1932x1916px.
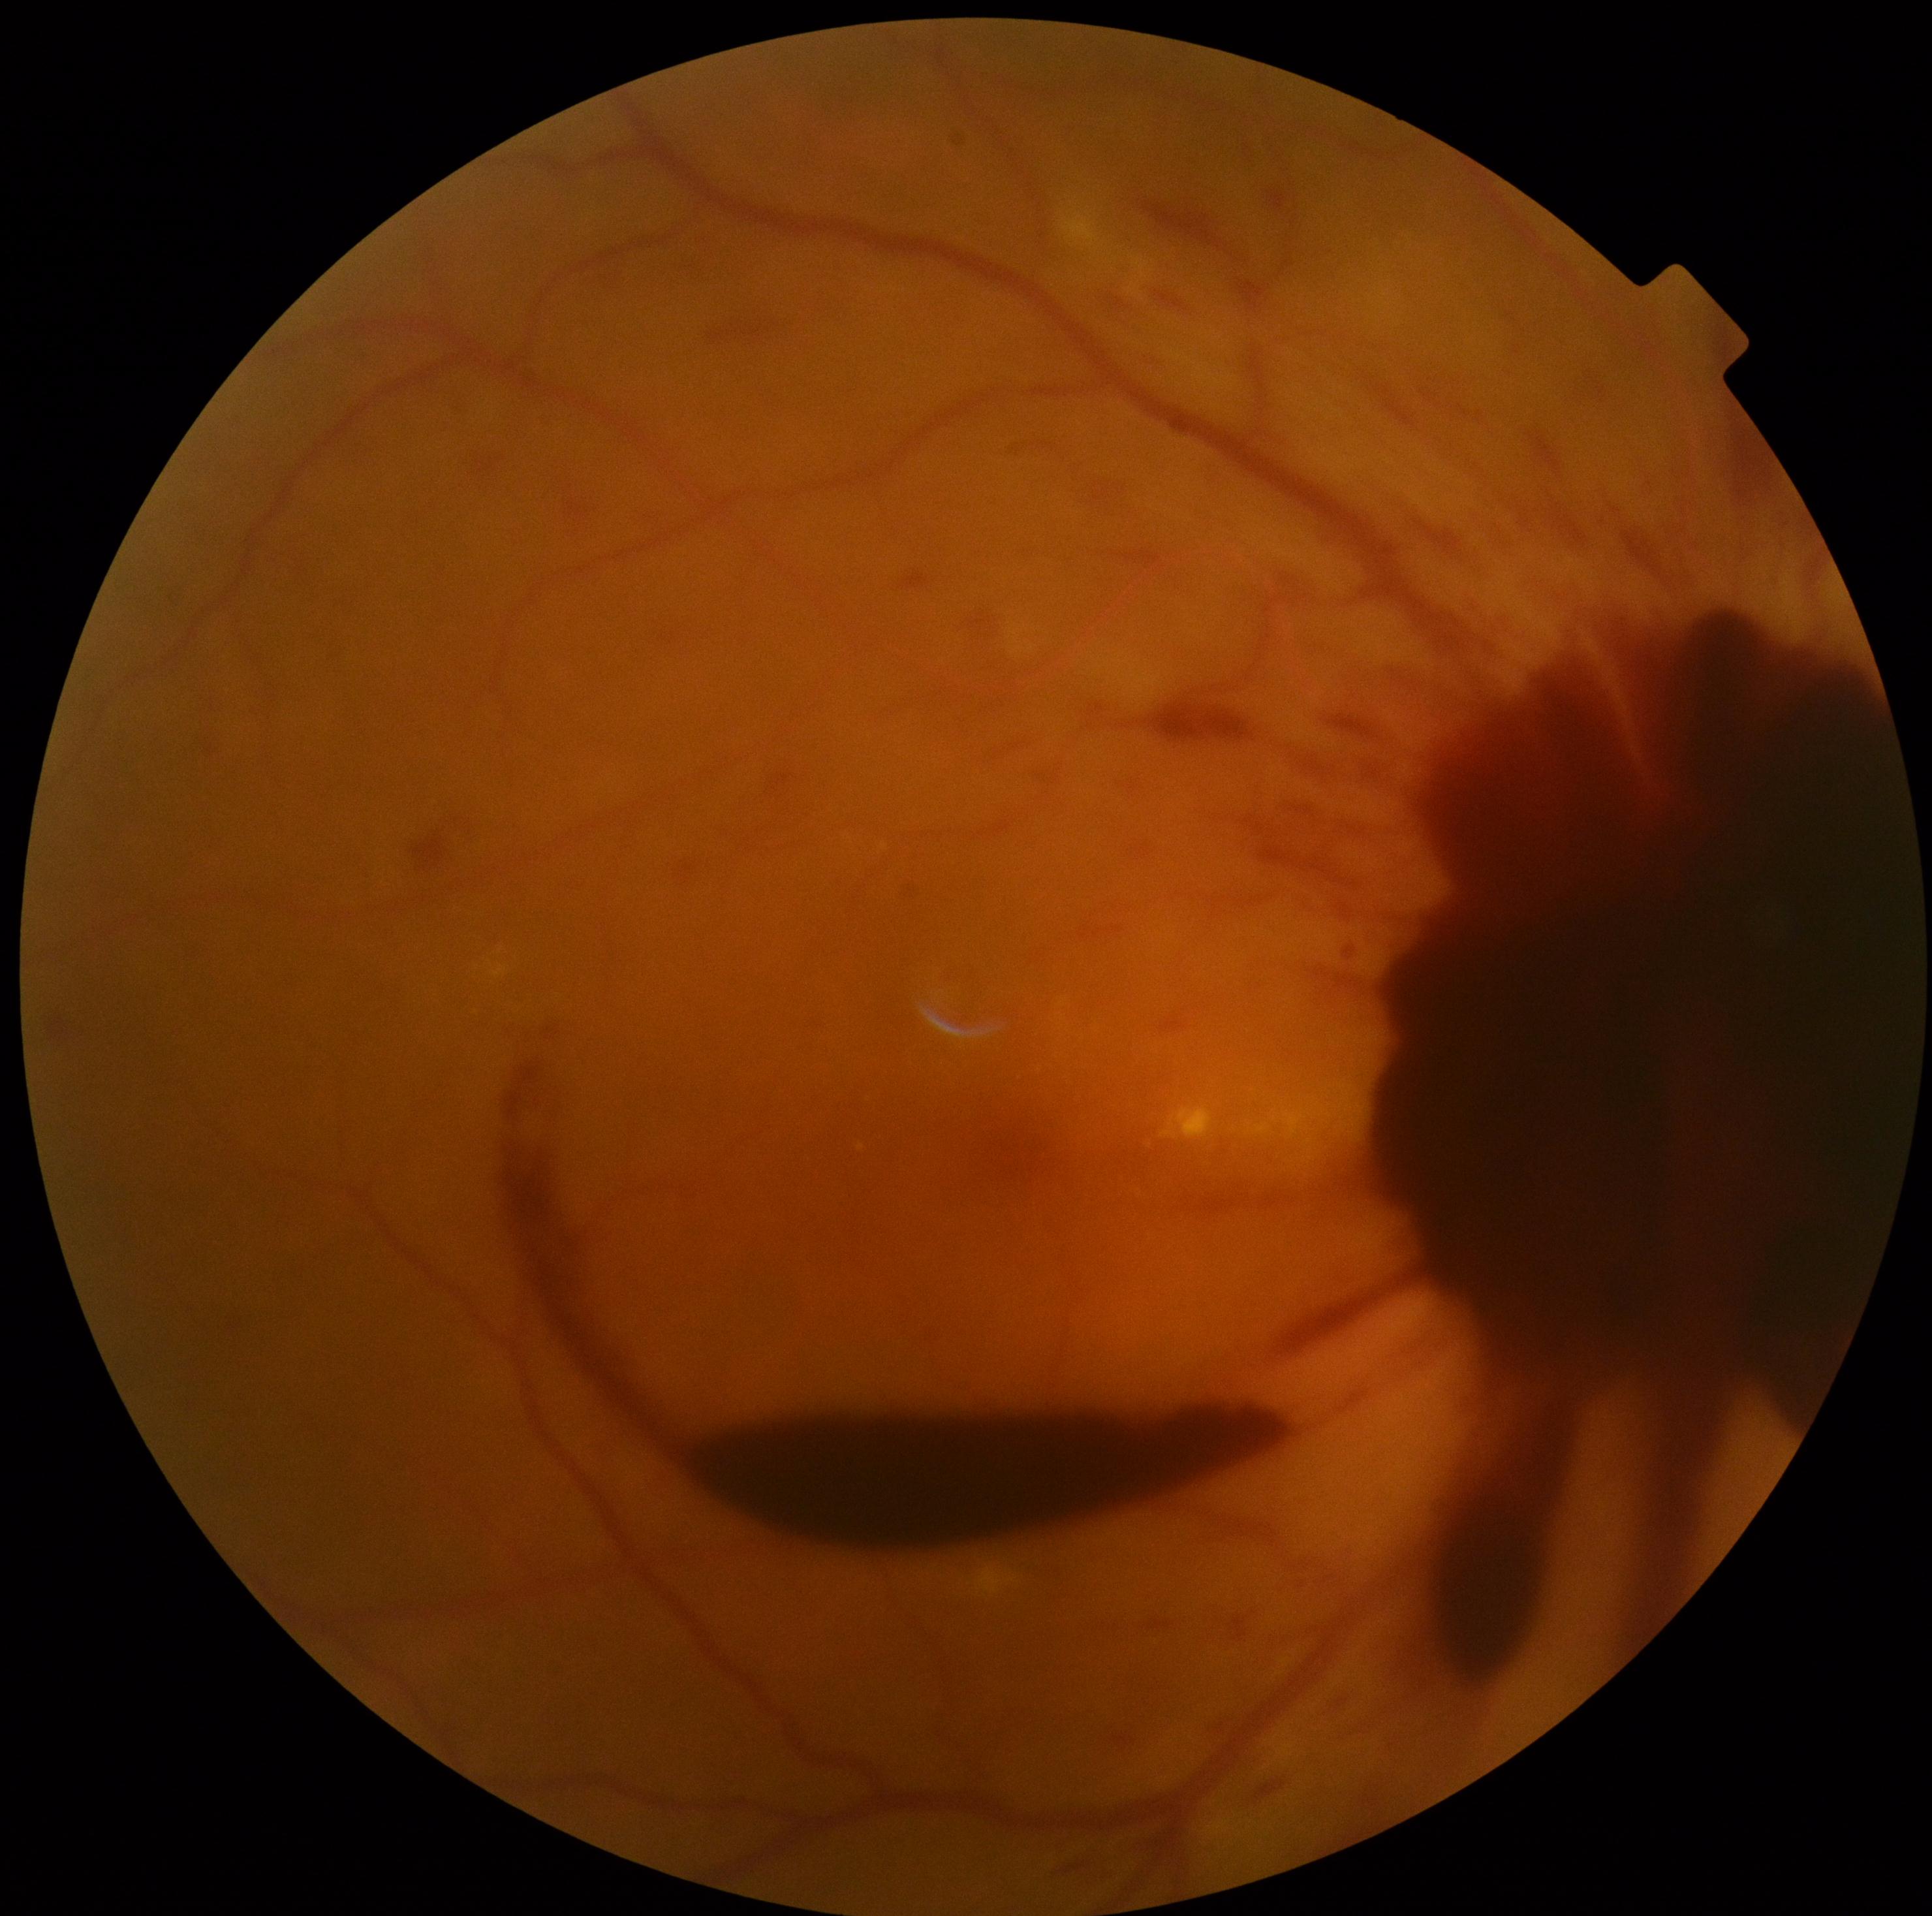
Annotations:
- DR class — proliferative diabetic retinopathy
- diabetic retinopathy grade — 4 (PDR)